Retinal fundus photograph. FOV: 45 degrees.
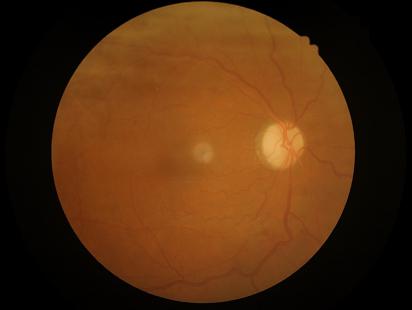 Vessels and details are readily distinguishable. Out of focus; structures are indistinct. Image quality is suboptimal. Illumination and color balance are good.